2352 by 1568 pixels; 45° field of view; color fundus image:
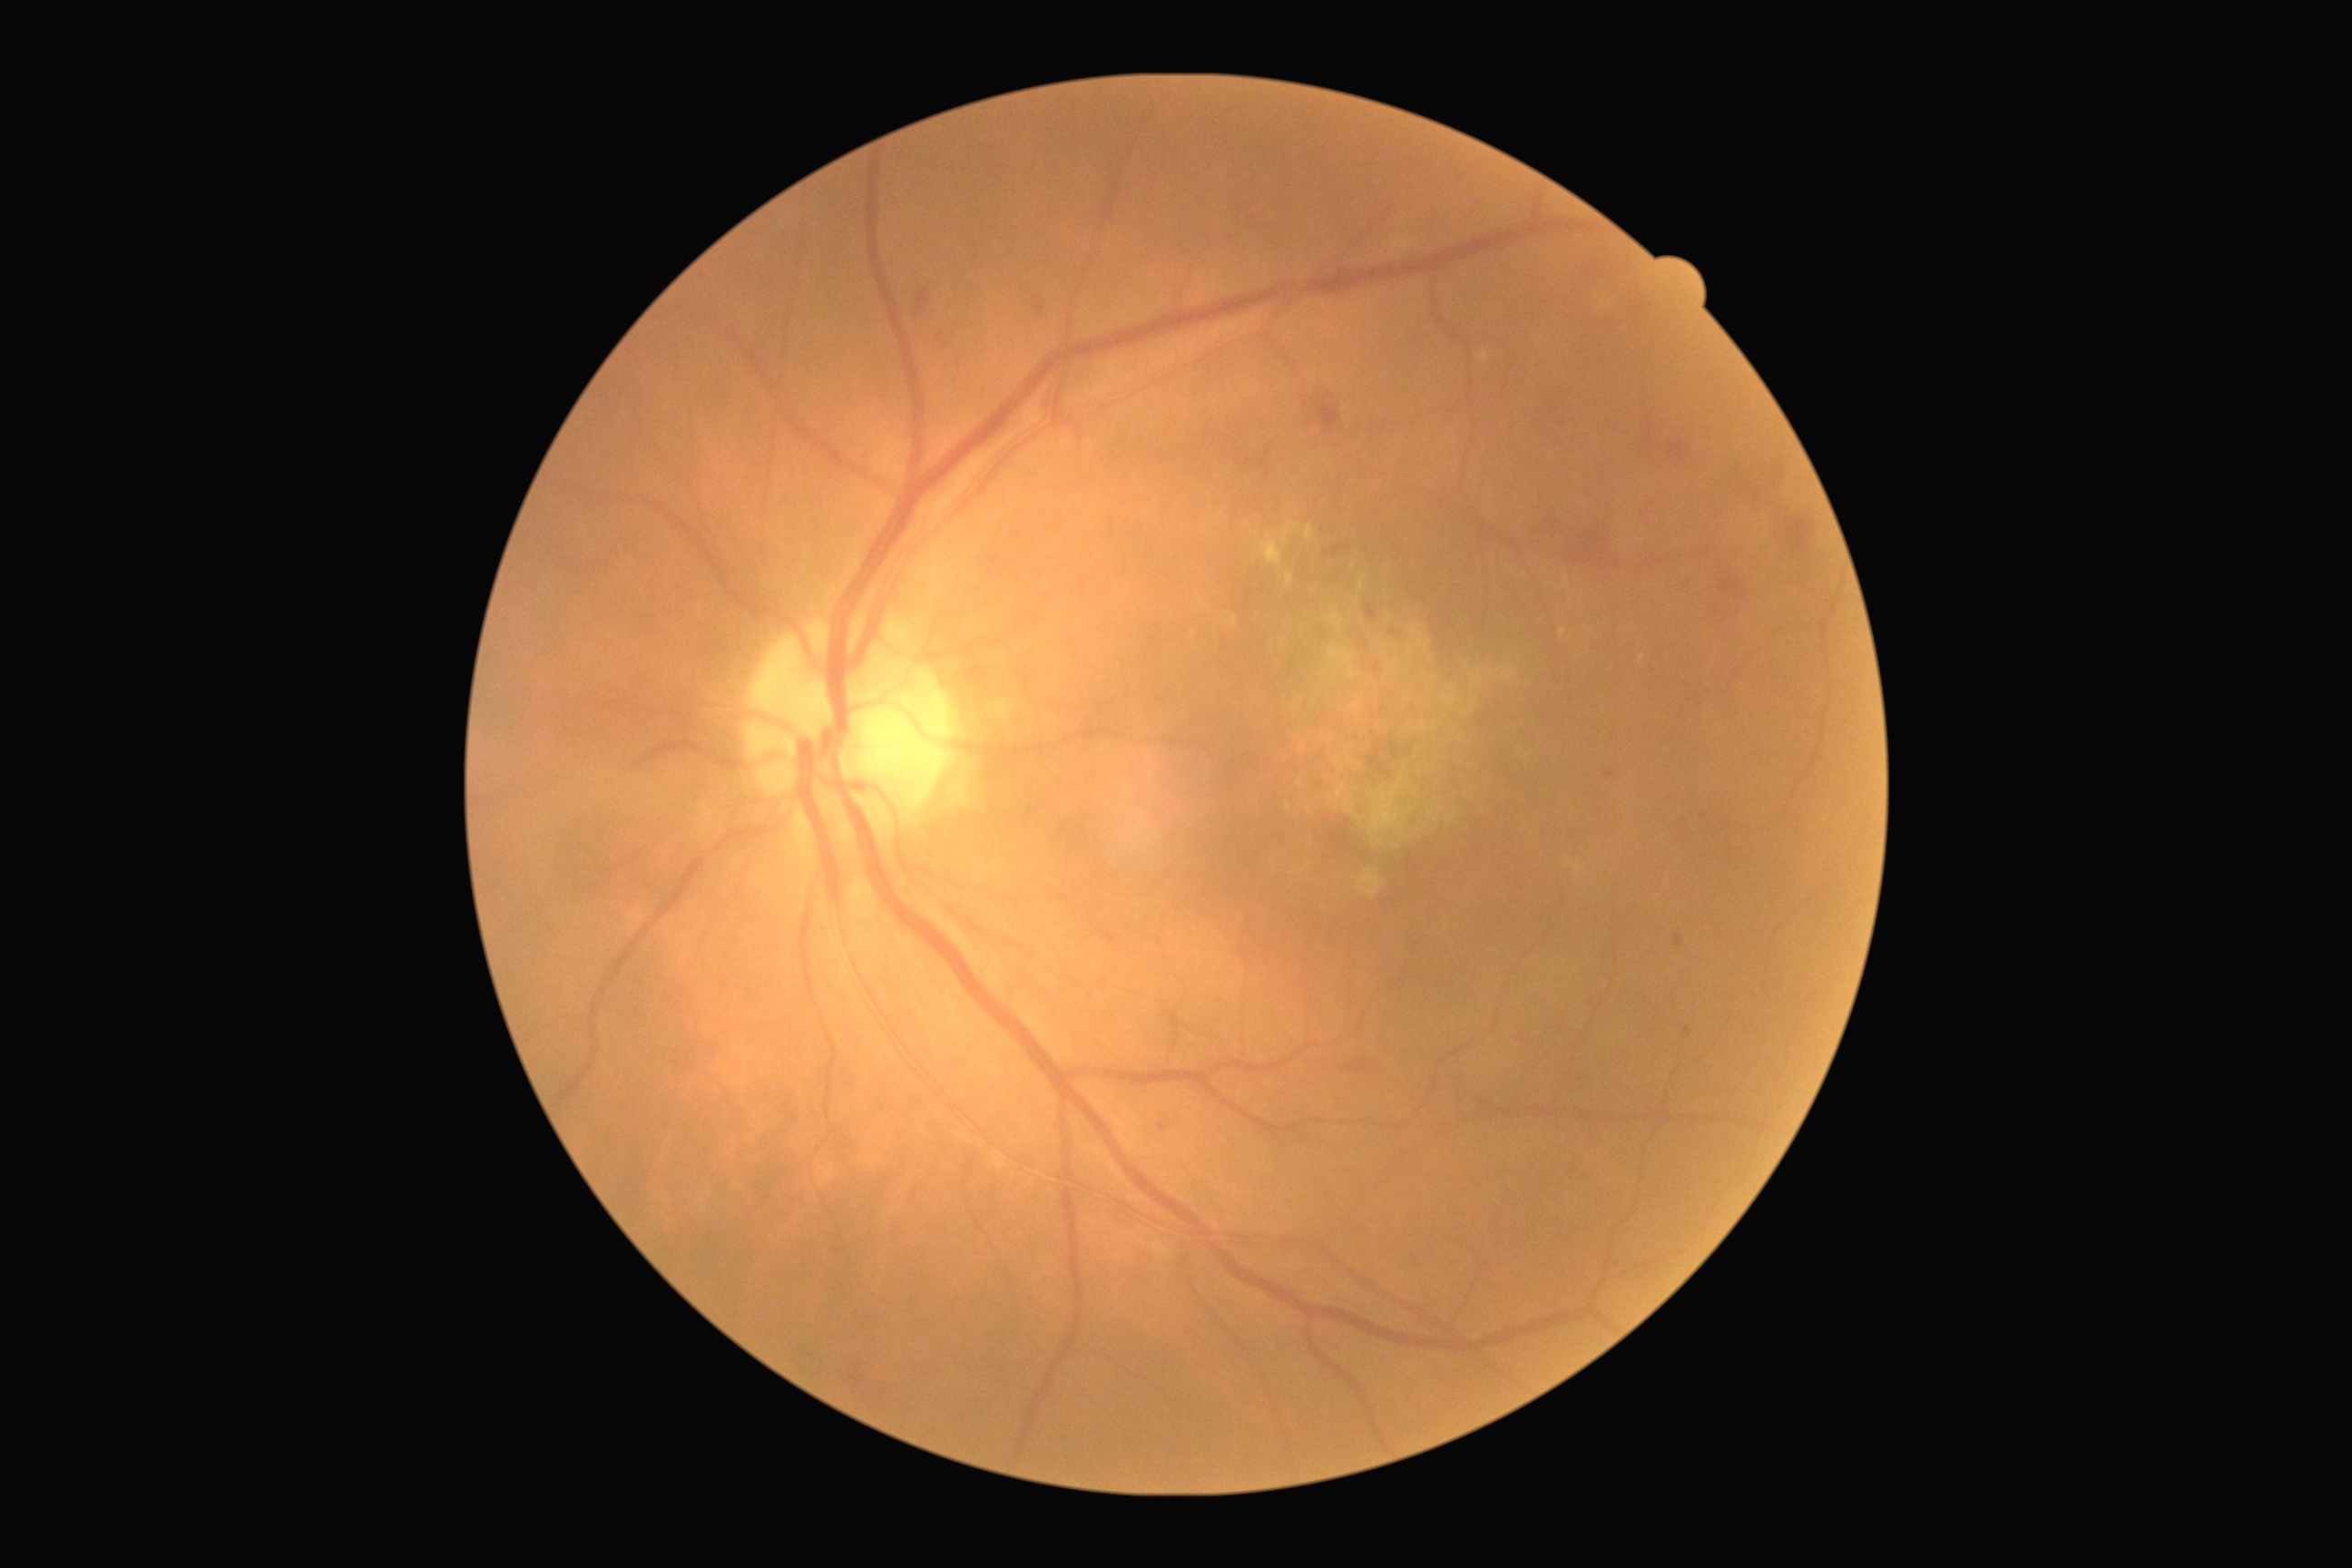
Retinopathy is 2/4 — more than just microaneurysms but less than severe NPDR.